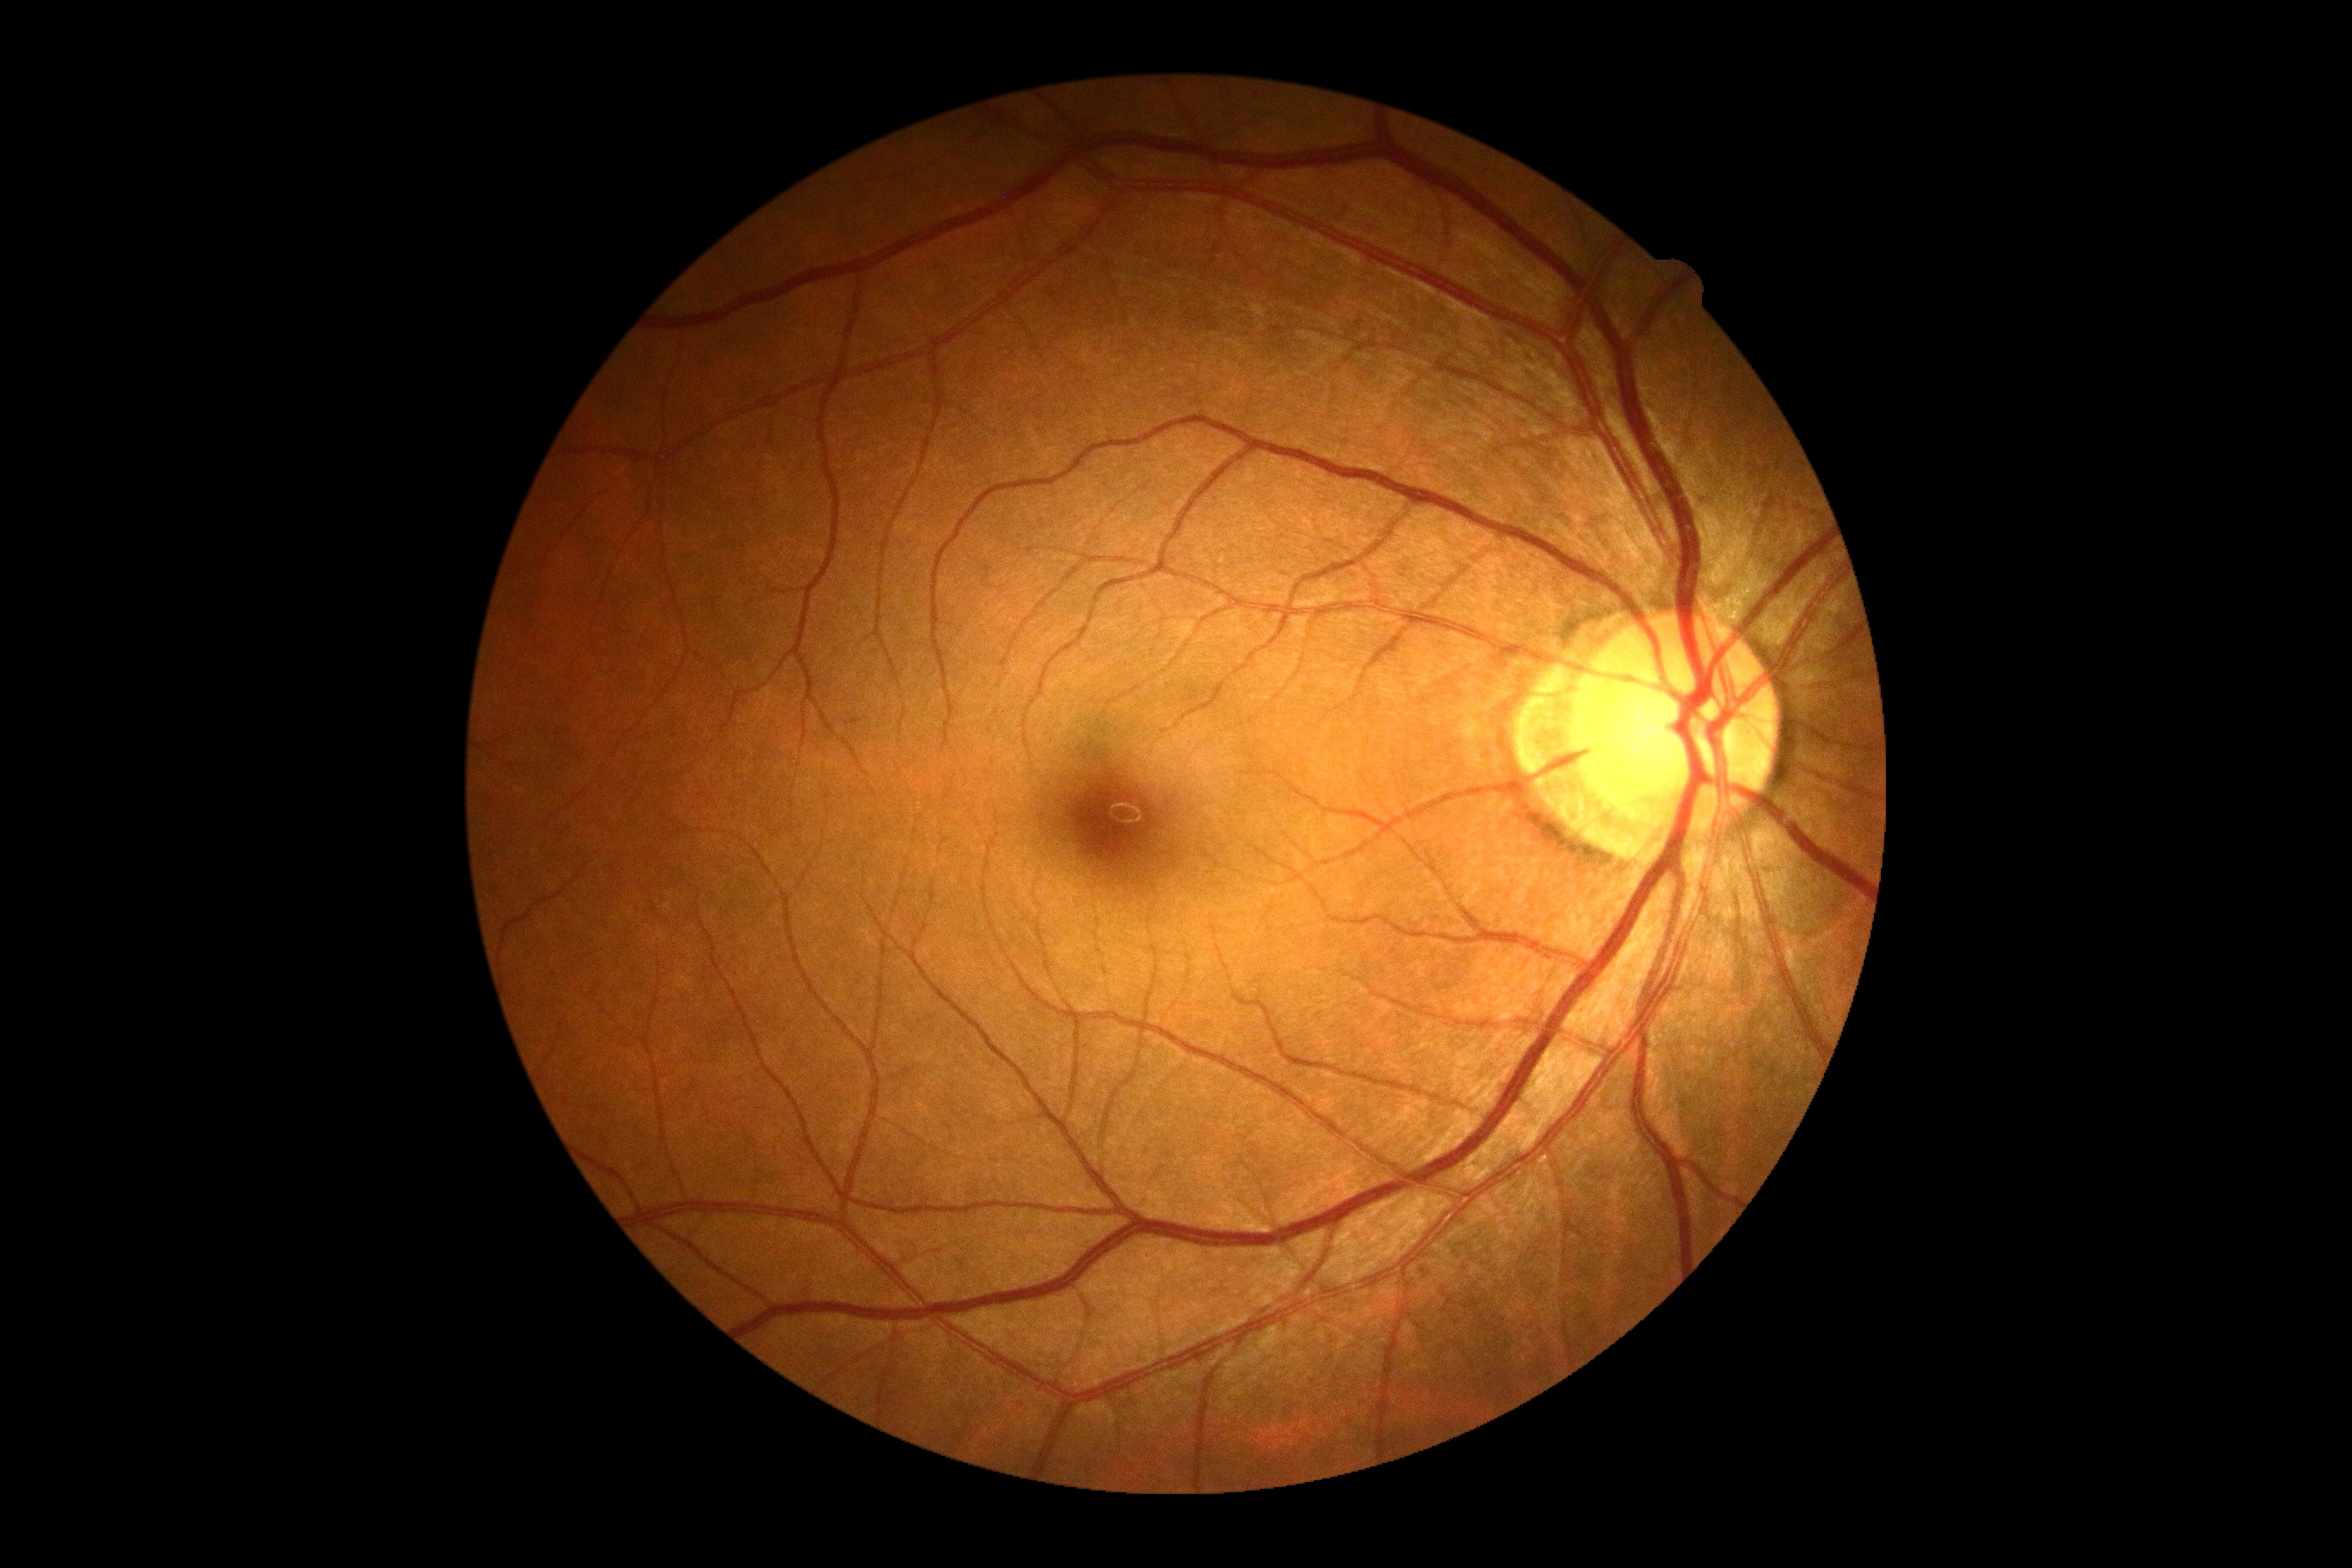

Diabetic retinopathy severity: grade 0 (no apparent retinopathy).